45° FOV:
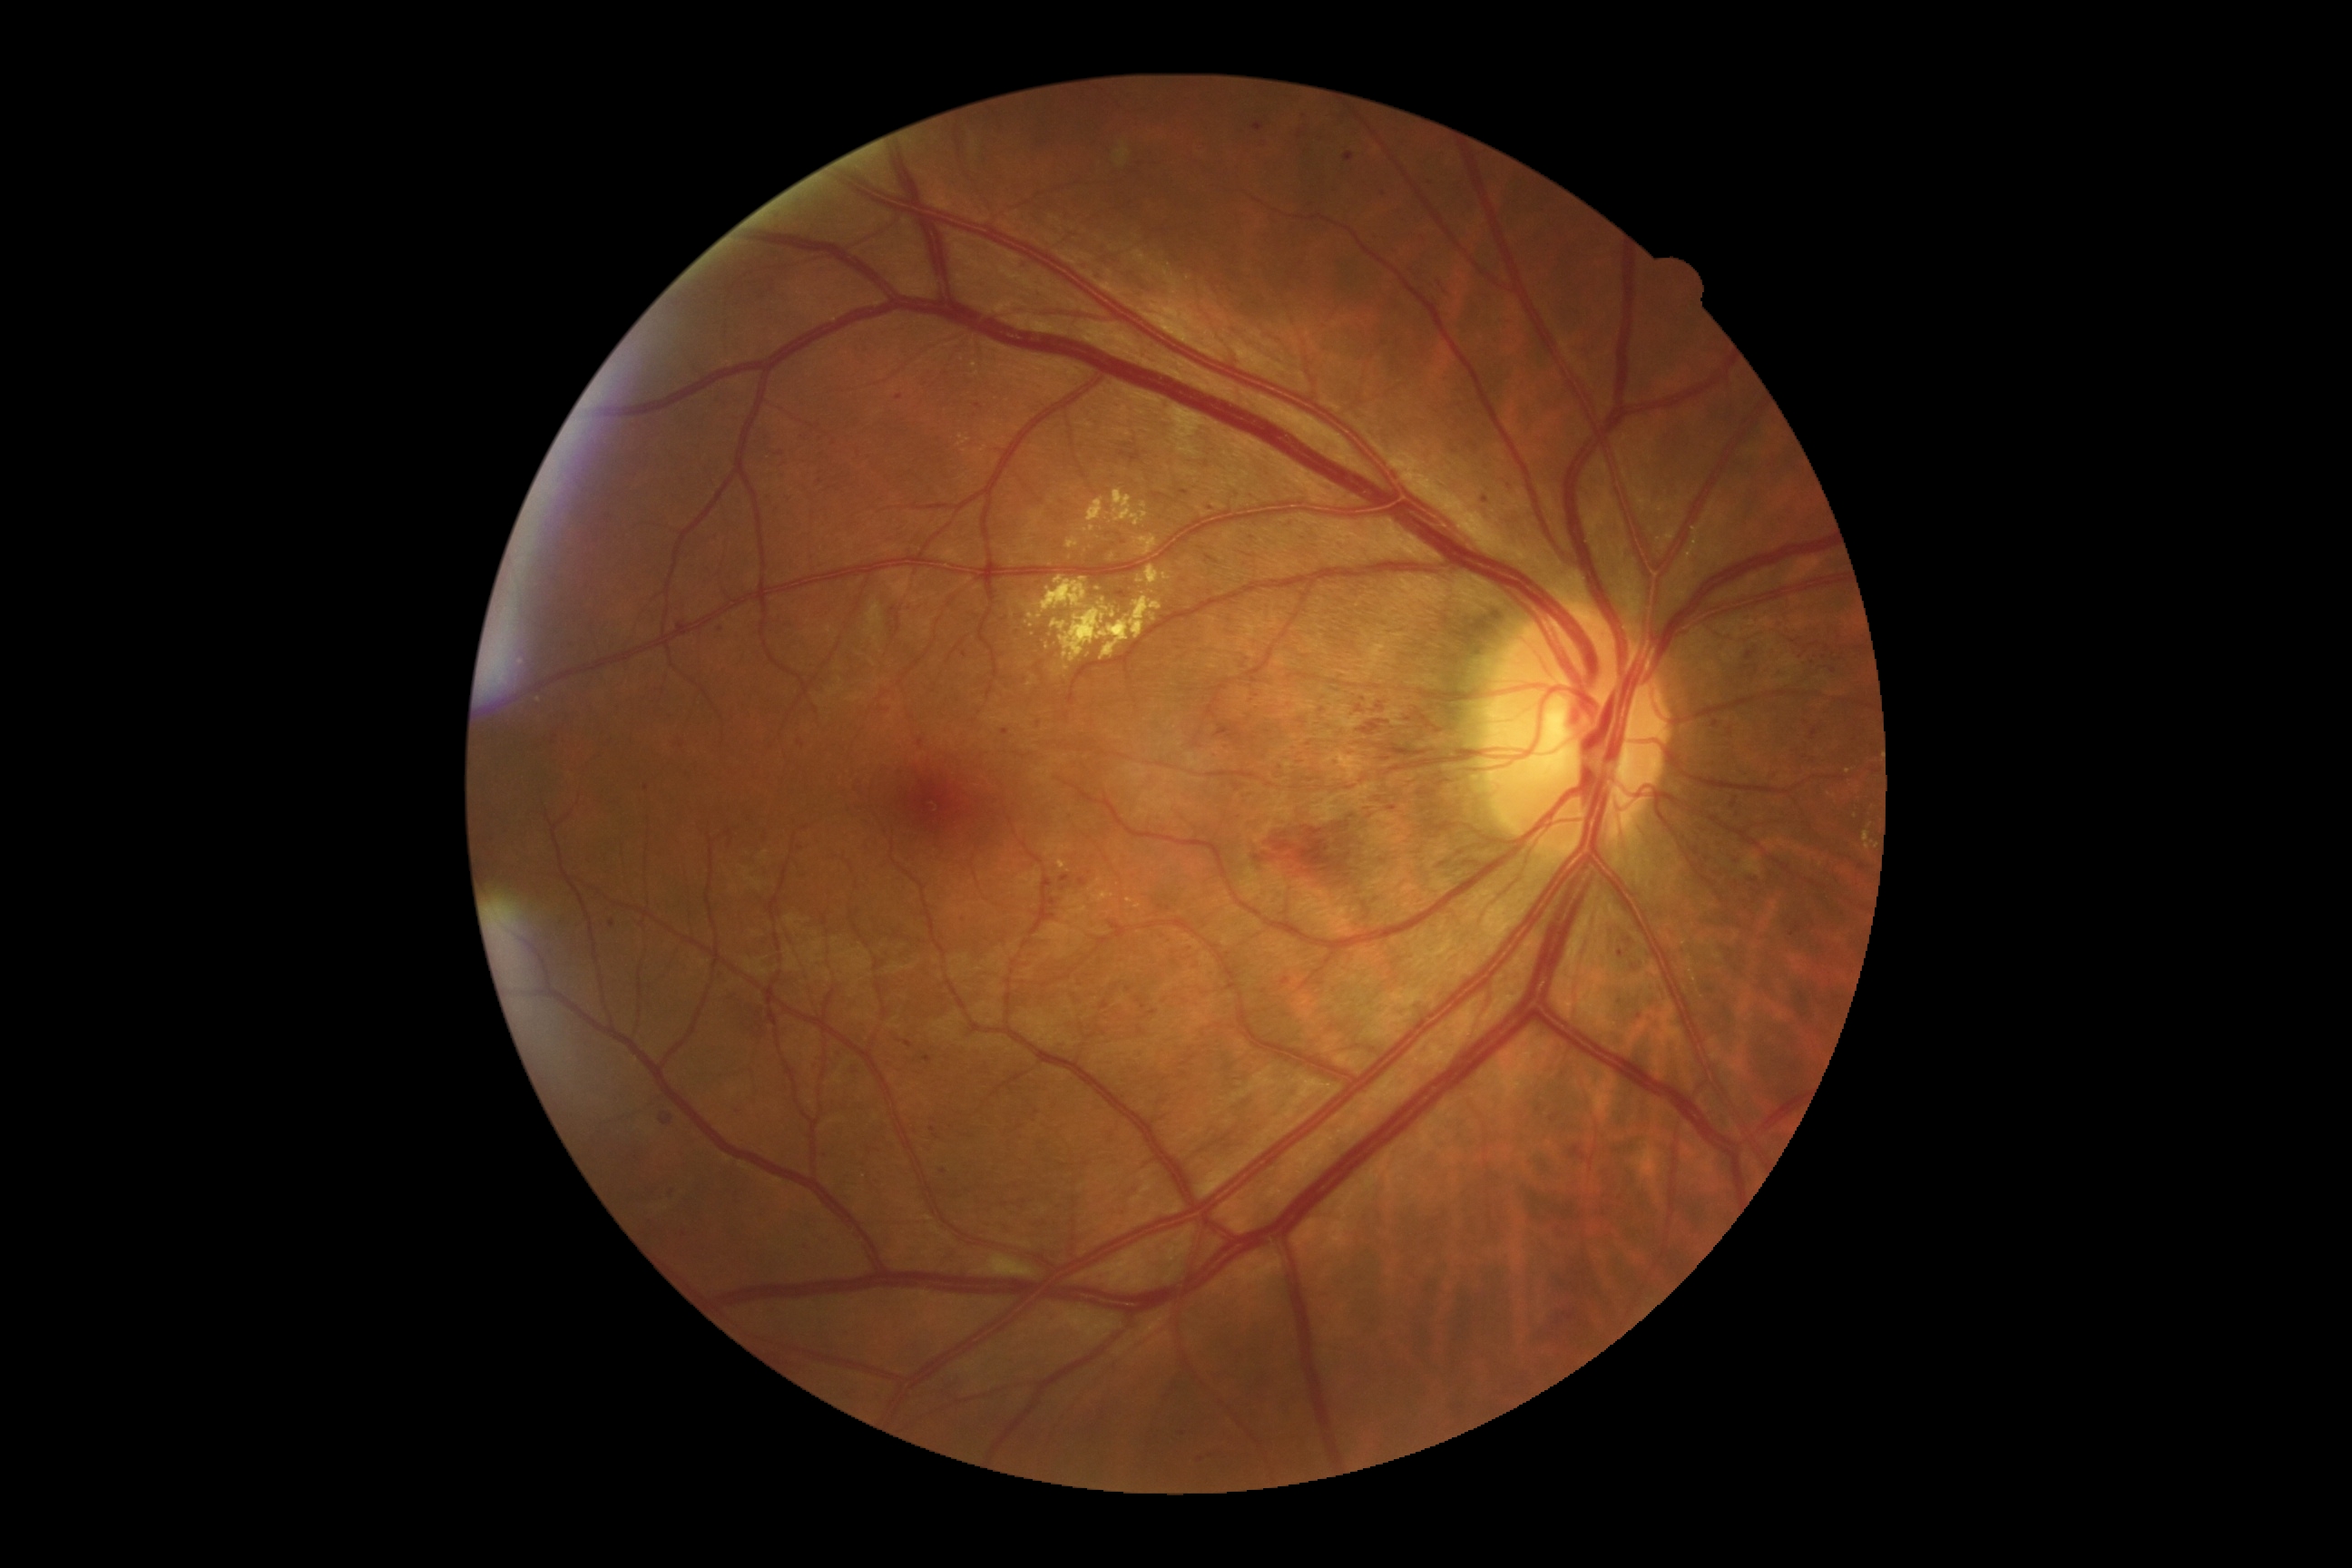

{"partial":true,"dr_grade":3,"lesions":{"ma":null,"he":[[819,1152,830,1162],[578,502,591,520],[1426,177,1438,188],[1110,921,1126,939],[975,404,983,409],[816,560,825,571],[1297,130,1304,139],[1614,992,1627,1006],[1740,640,1761,665],[1344,153,1355,162],[1150,1010,1159,1015],[1300,112,1309,121],[890,607,897,616],[1262,687,1446,781]],"he_small_approx":[[1024,1202],[908,608],[1214,756],[1067,717]],"ex":[[975,447,986,455],[1665,531,1676,542],[1059,596,1162,662],[1052,620,1068,632],[1150,614,1157,622],[1090,879,1102,892],[1146,567,1161,585],[1685,525,1703,571]],"ex_small_approx":[[1139,580],[1048,647],[973,365],[977,374],[1138,907],[1830,796]],"se":[[975,1255,1039,1279],[1115,142,1130,168]]}}